Pediatric retinal photograph (wide-field):
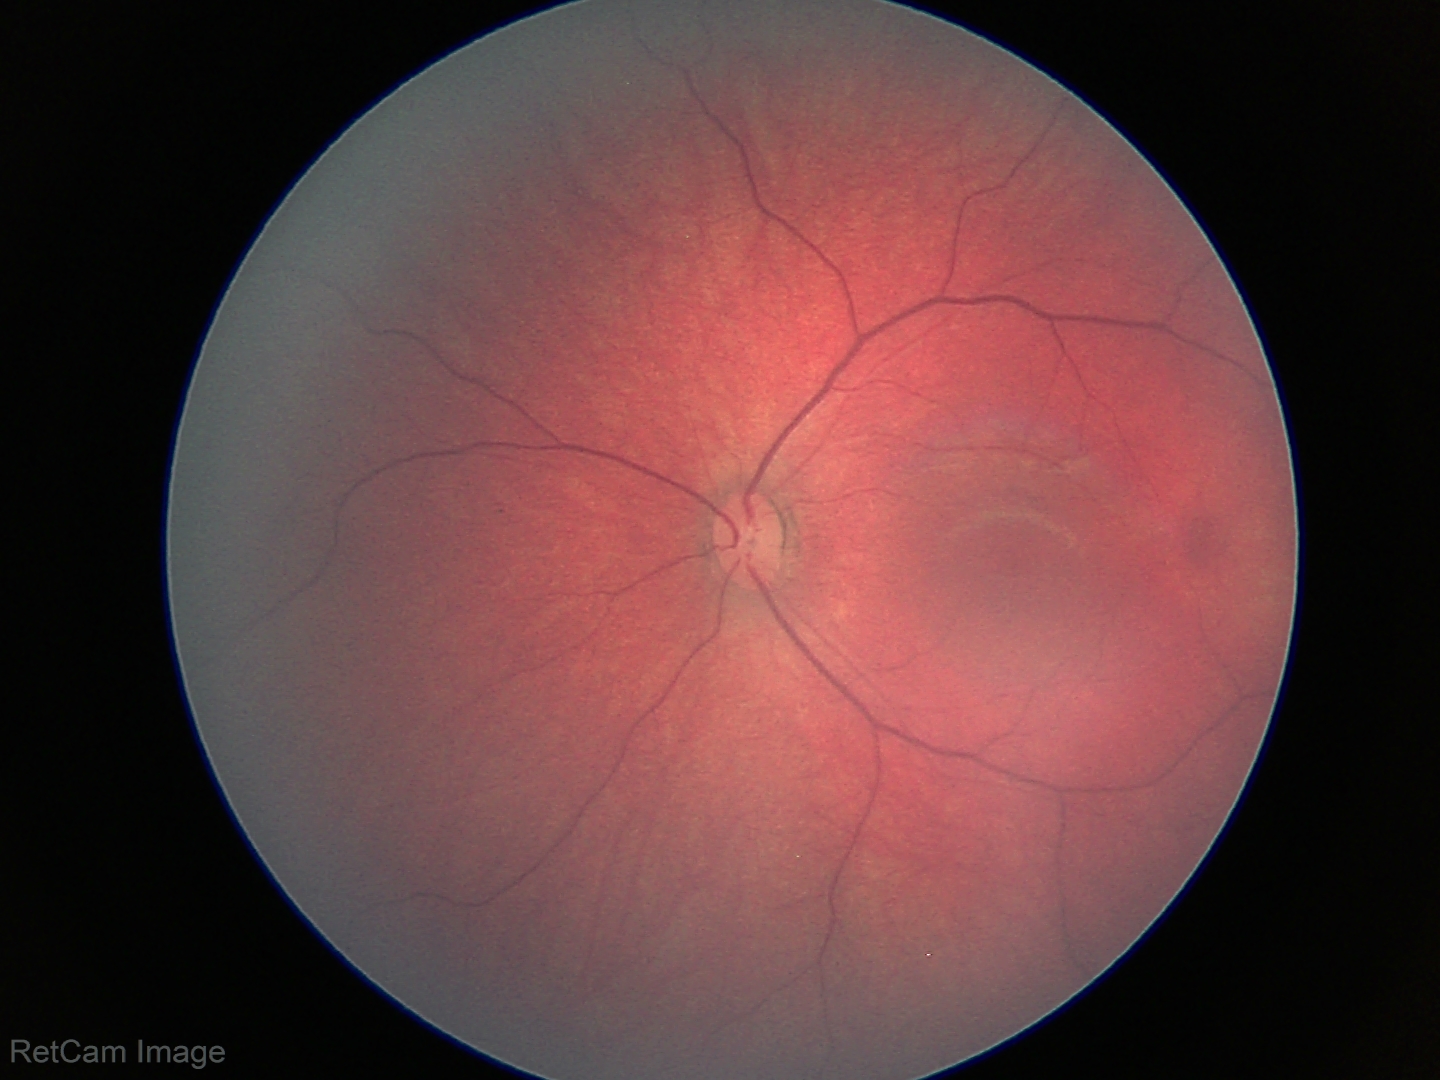 Physiological retinal appearance for postconceptual age.